Diabetic retinopathy graded by the modified Davis classification — 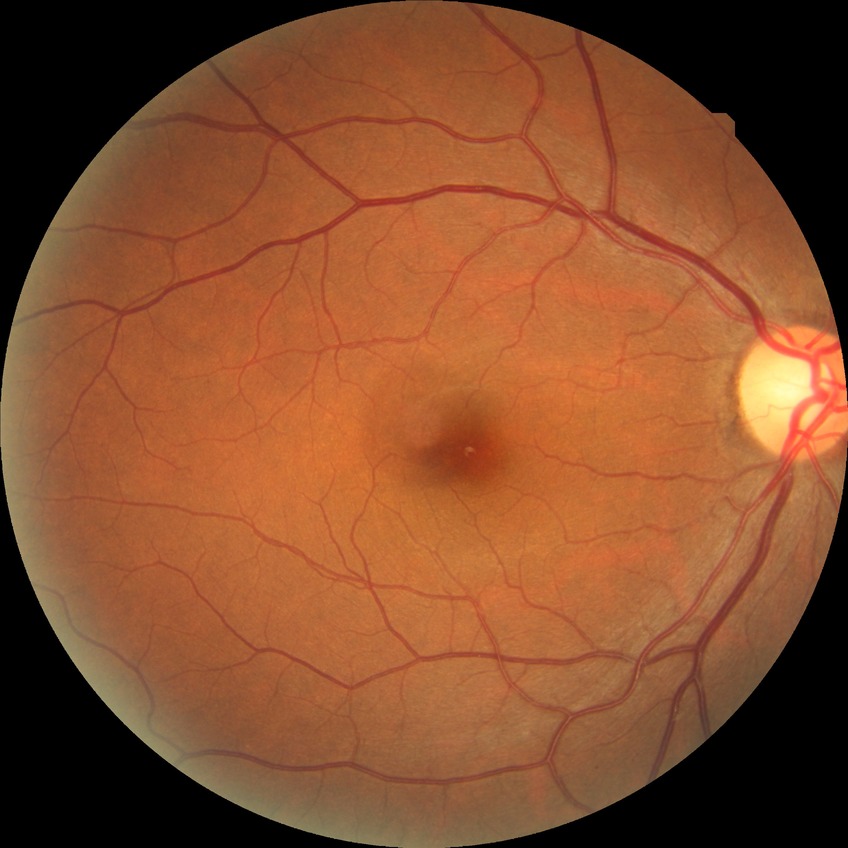
Diabetic retinopathy (DR) is no diabetic retinopathy (NDR).